Infant wide-field retinal image. 1240 by 1240 pixels: 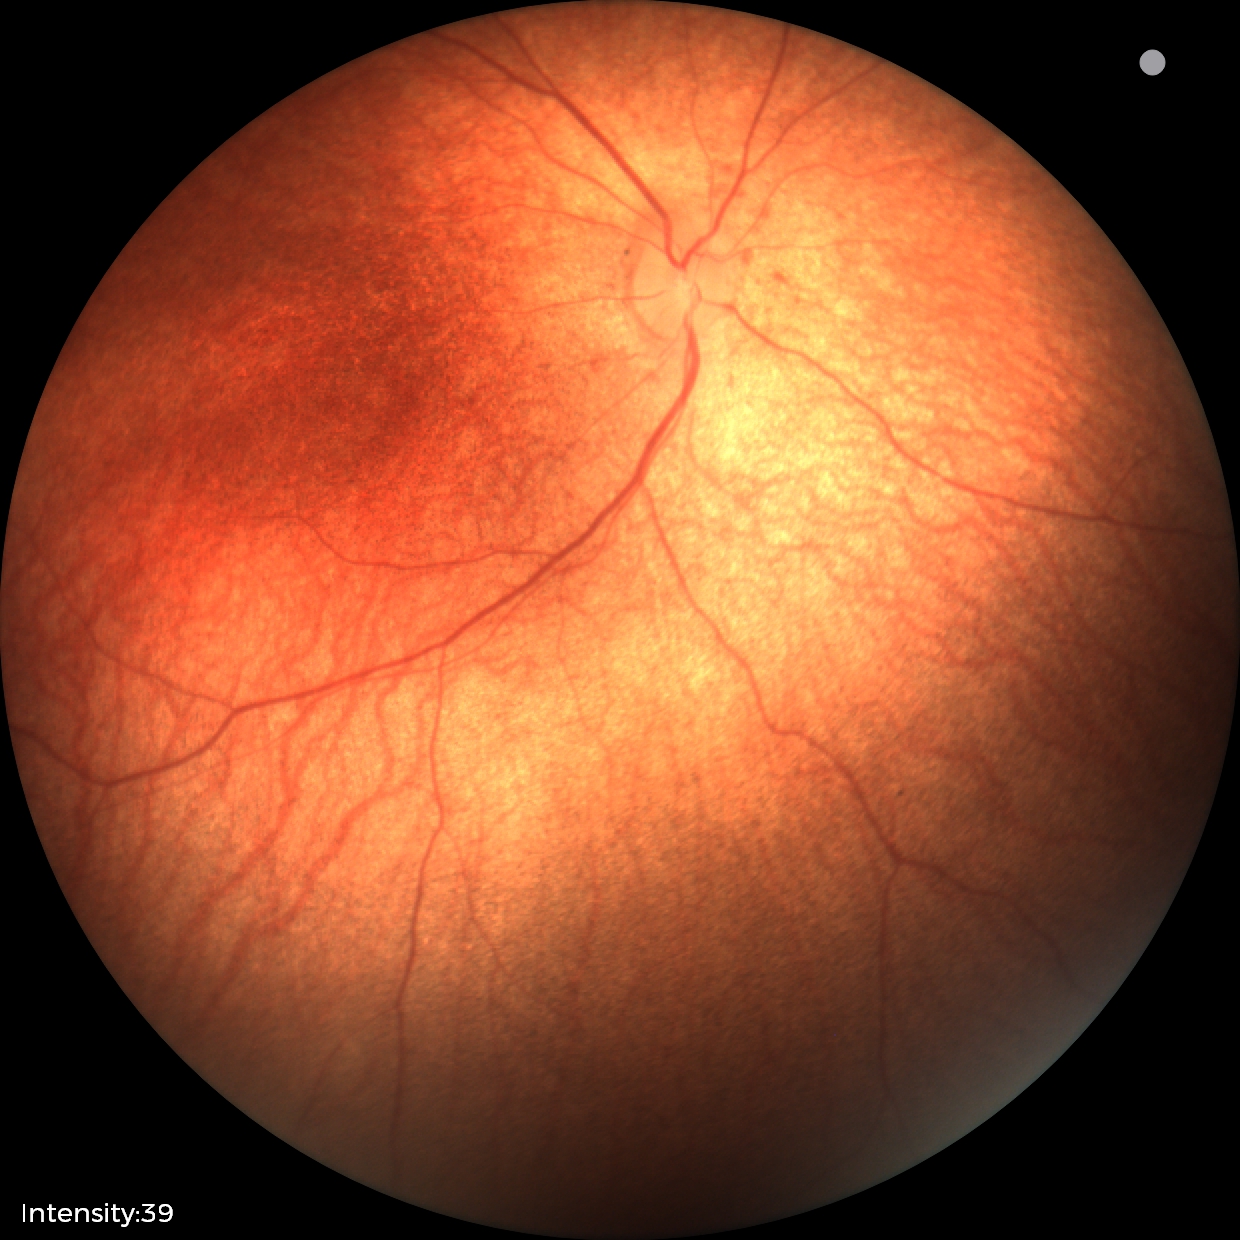 Finding = no pathology identified.